45-degree field of view.
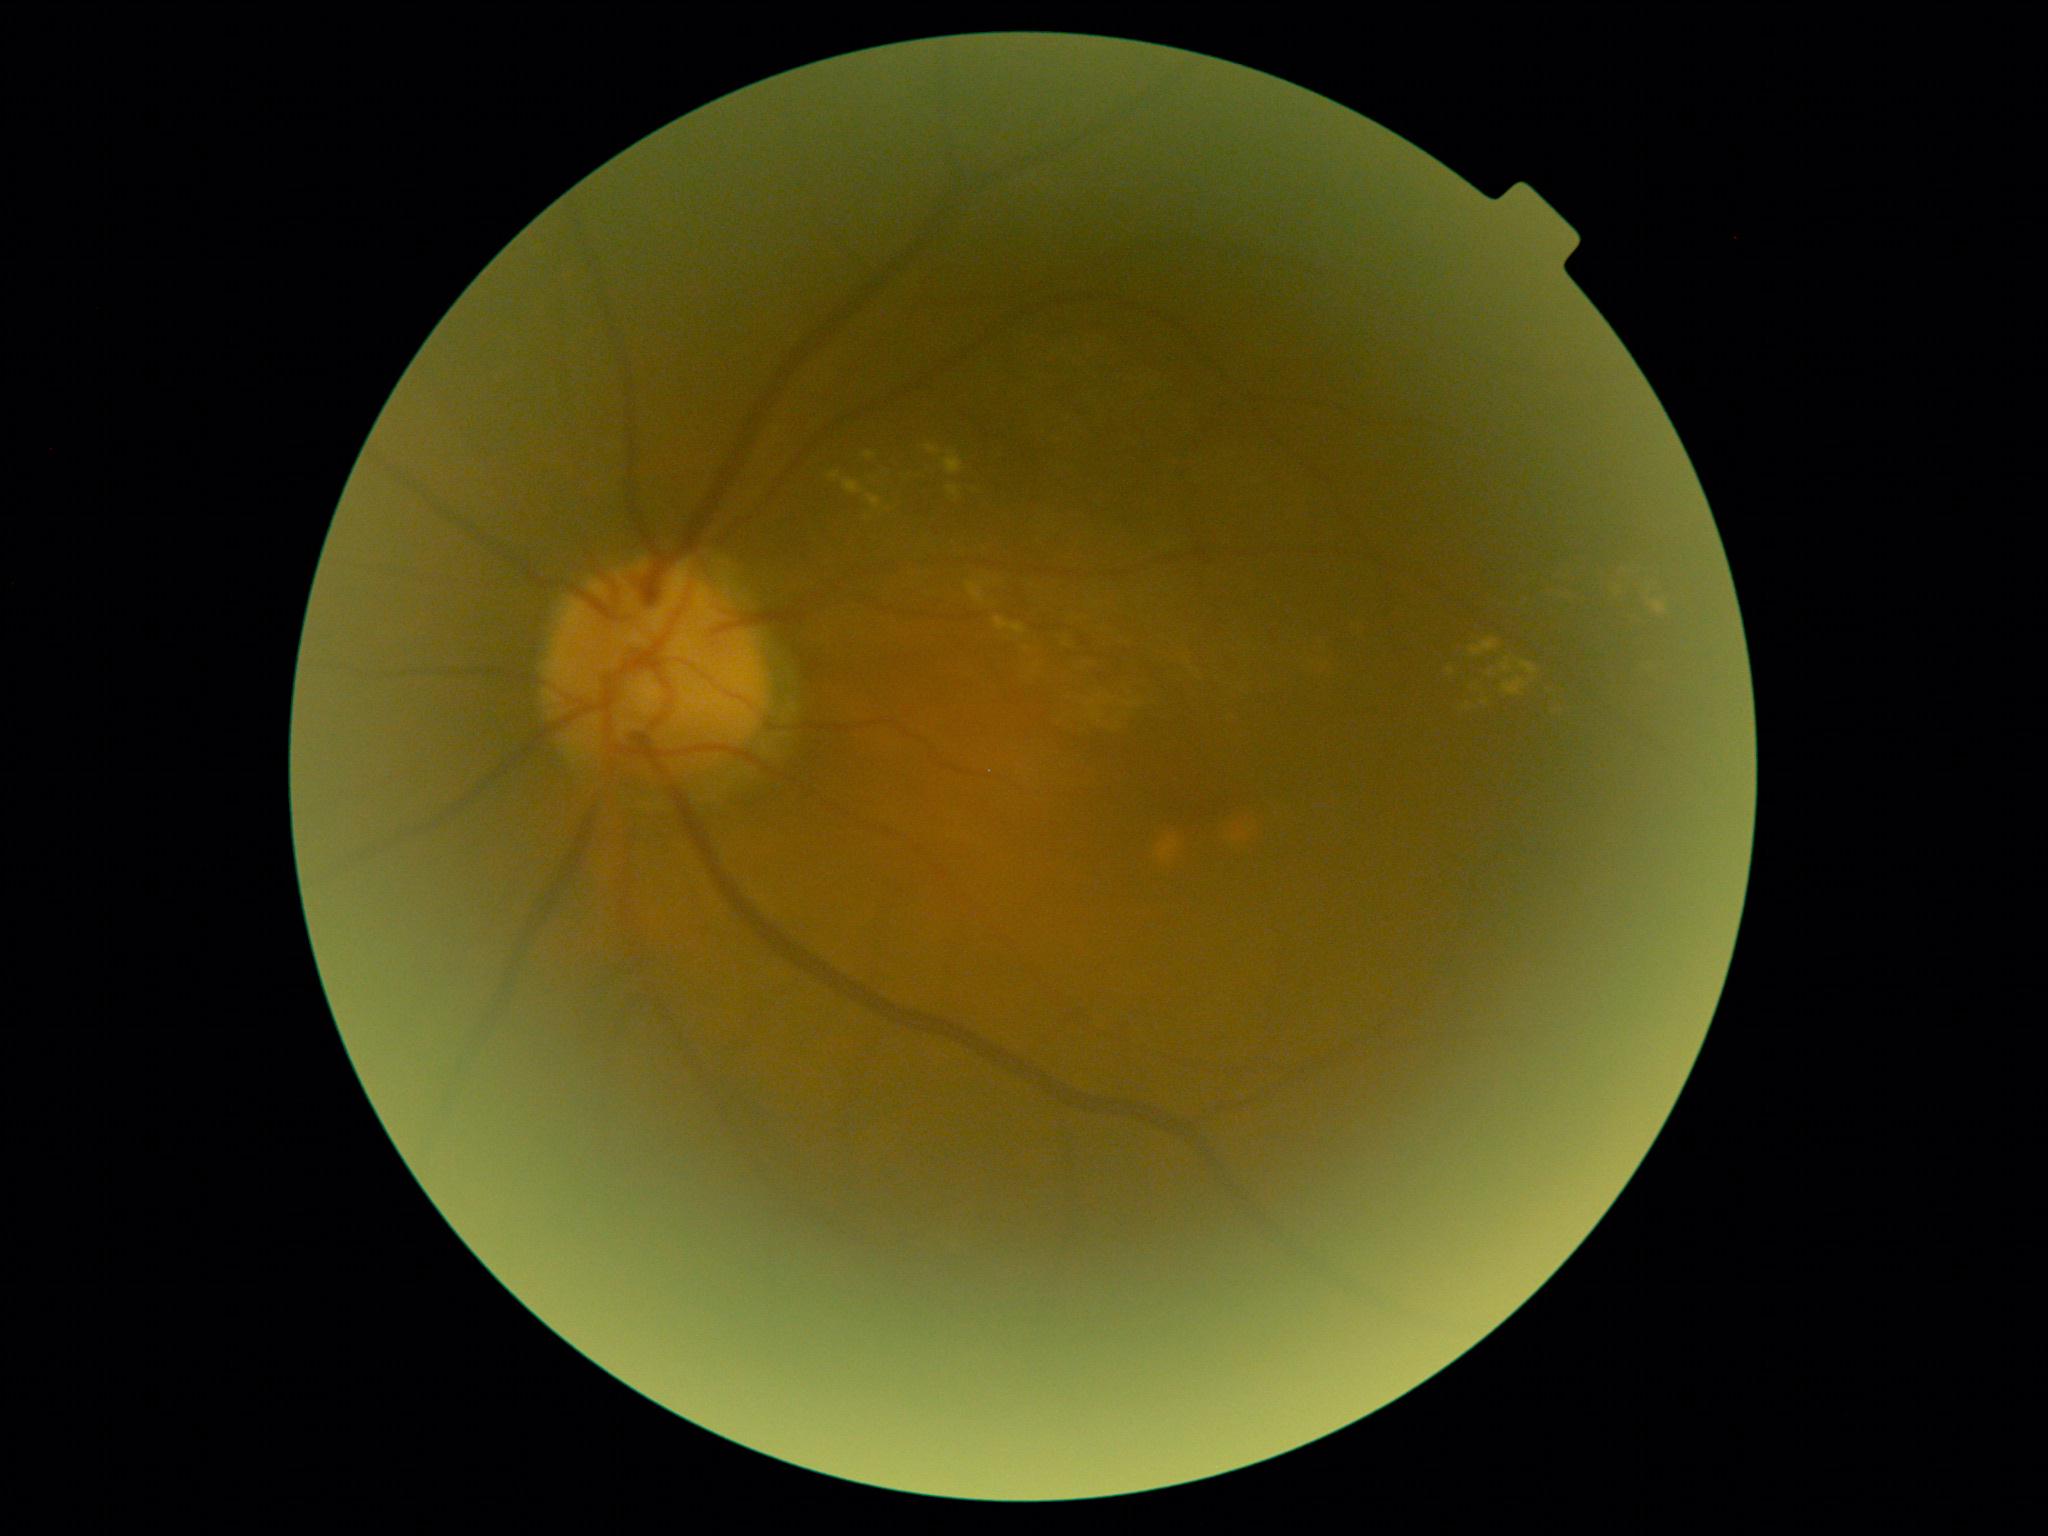
DR severity: 2.